FOV: 45 degrees, 2352 by 1568 pixels: 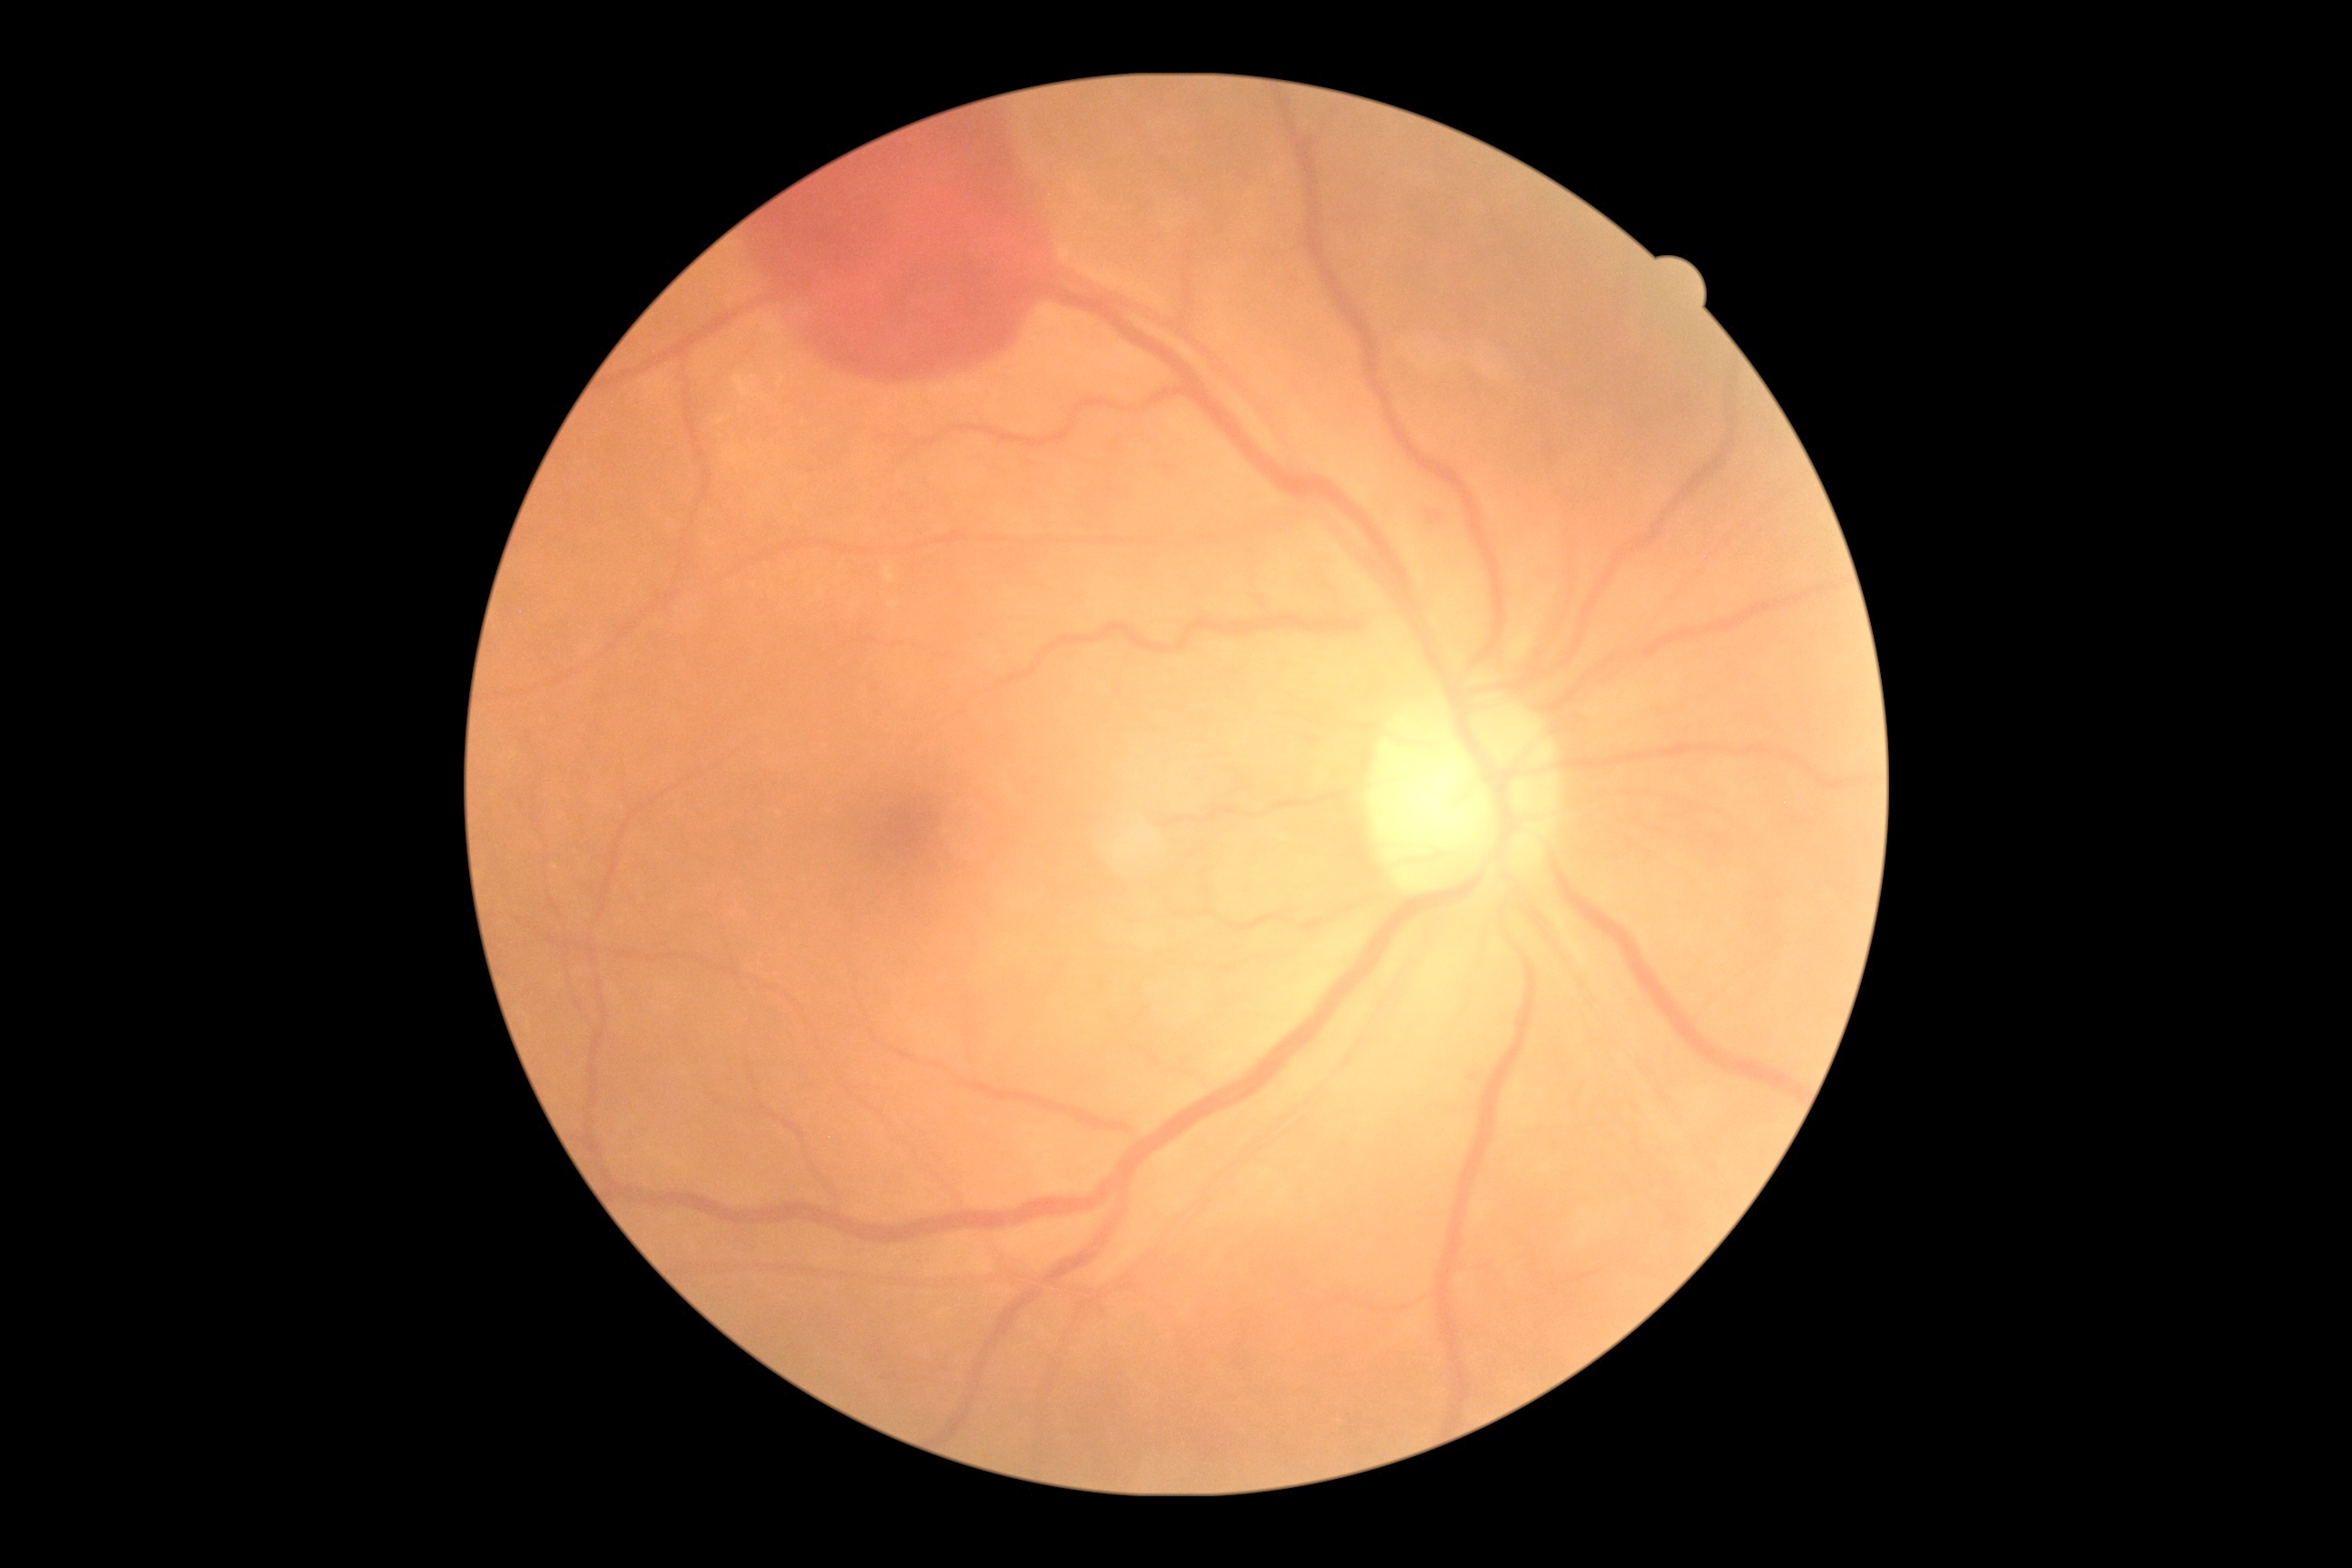 Annotations:
* retinopathy: 4/4
* DR class: proliferative diabetic retinopathy